240x240px:
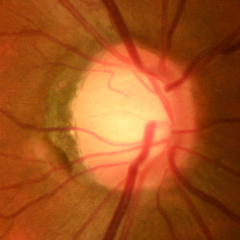
Q: Does this eye have glaucoma?
A: No glaucoma.